Nonmydriatic; modified Davis grading; camera: NIDEK AFC-230; FOV: 45 degrees; fundus photo:
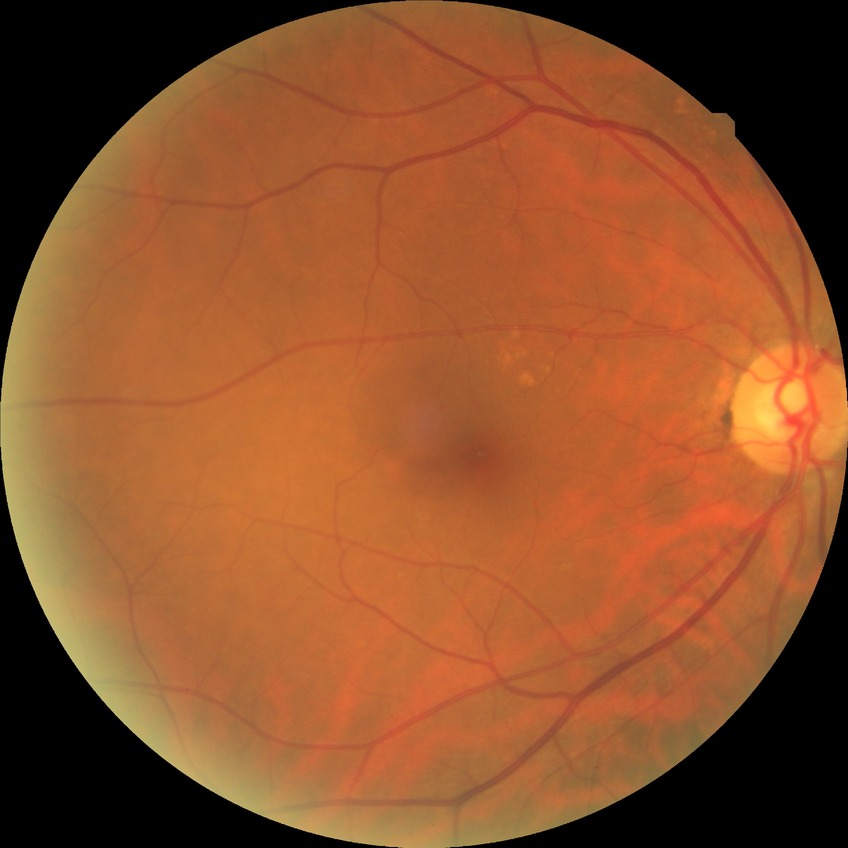 diabetic retinopathy (DR): no diabetic retinopathy (NDR).